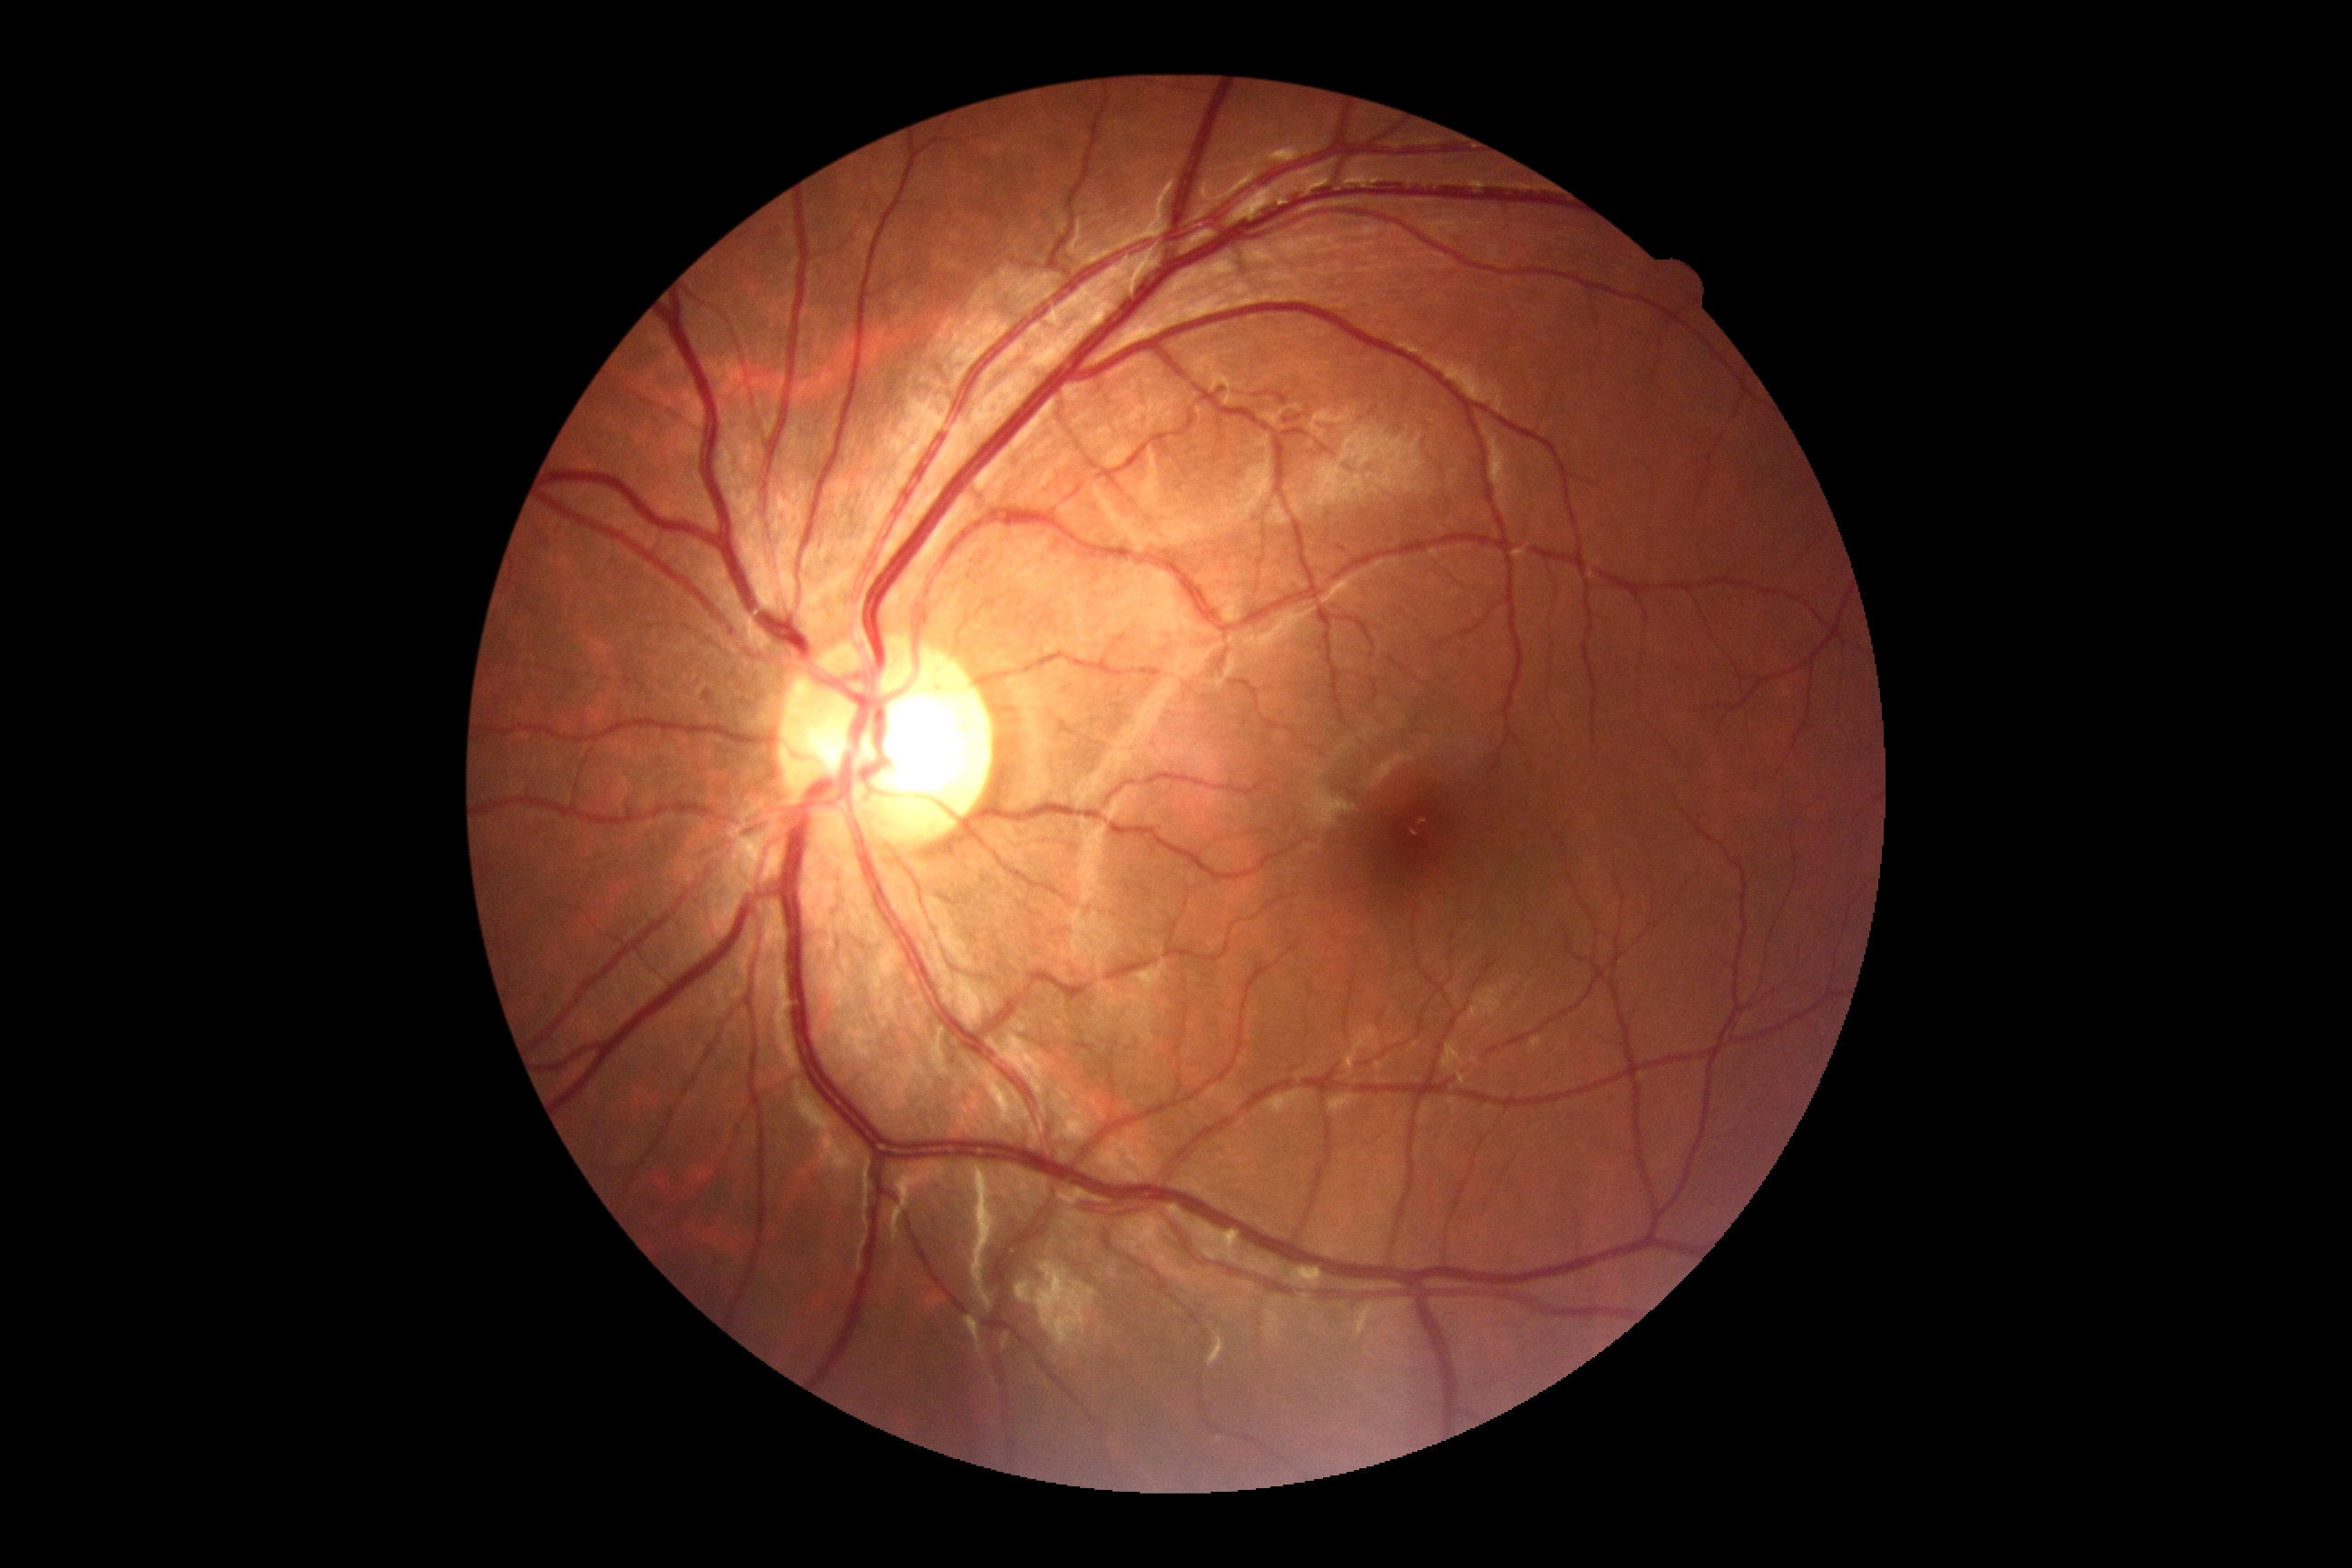 {"dr_grade": "grade 0 (no apparent retinopathy) — no visible signs of diabetic retinopathy", "dr_impression": "no signs of DR"}